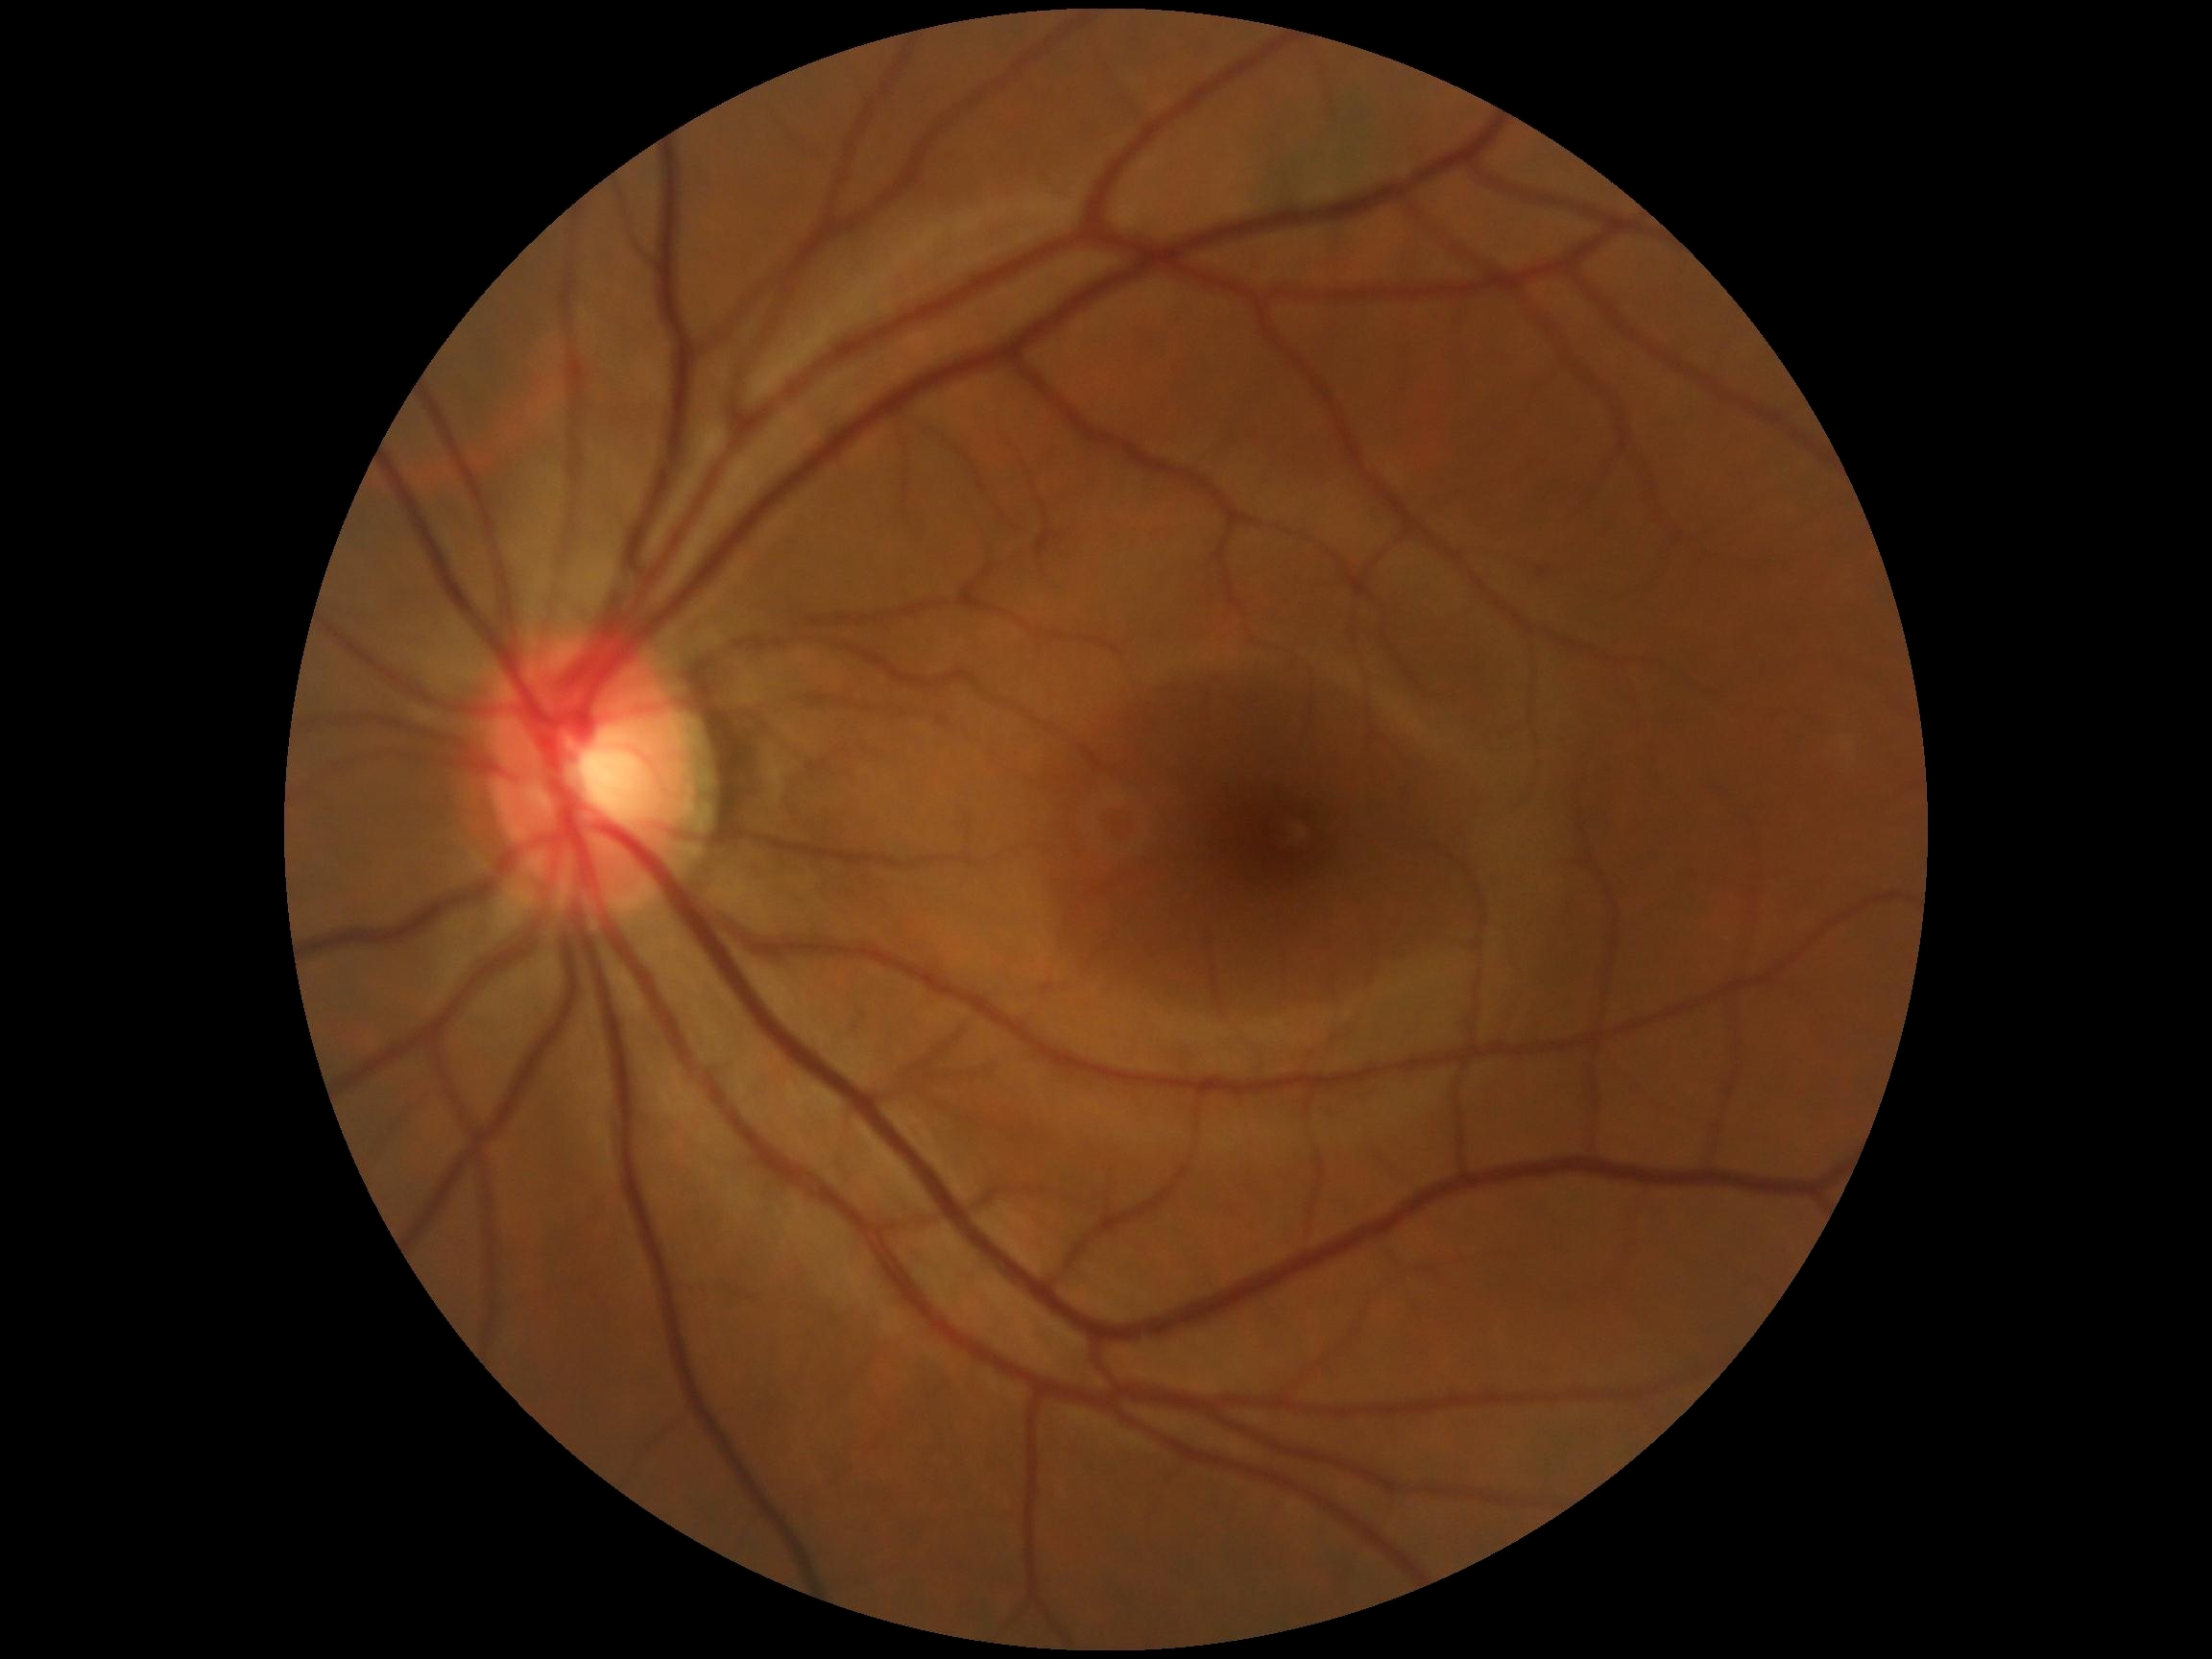
No diabetic retinal disease findings. Diabetic retinopathy severity: grade 0.